Wide-field fundus photograph of an infant: 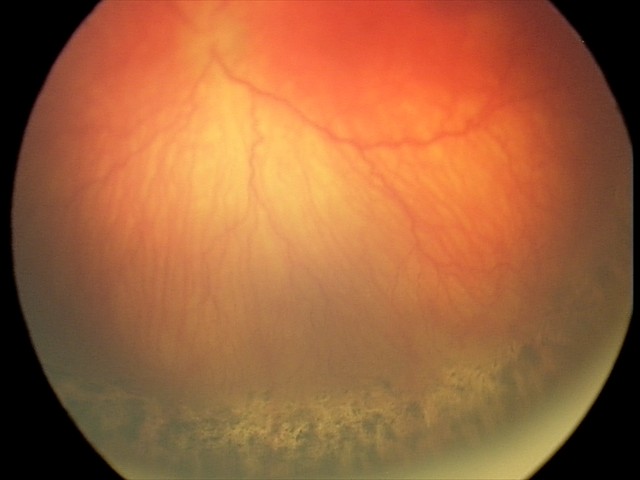
From an examination with diagnosis of aggressive retinopathy of prematurity.
Plus disease was diagnosed.